RetCam wide-field infant fundus image.
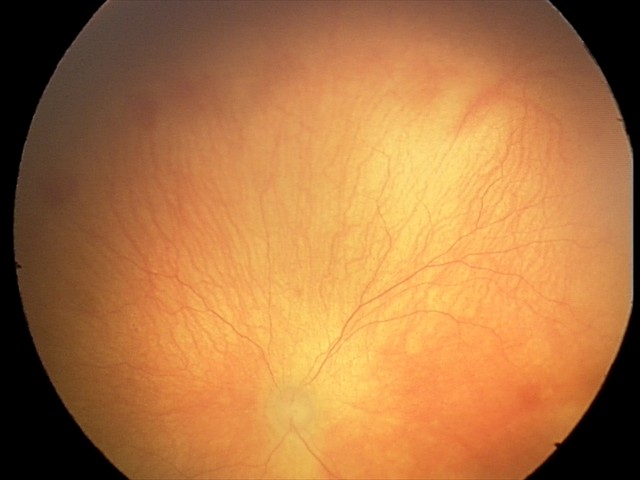
Screening series with aggressive retinopathy of prematurity. With plus disease.